CFP.
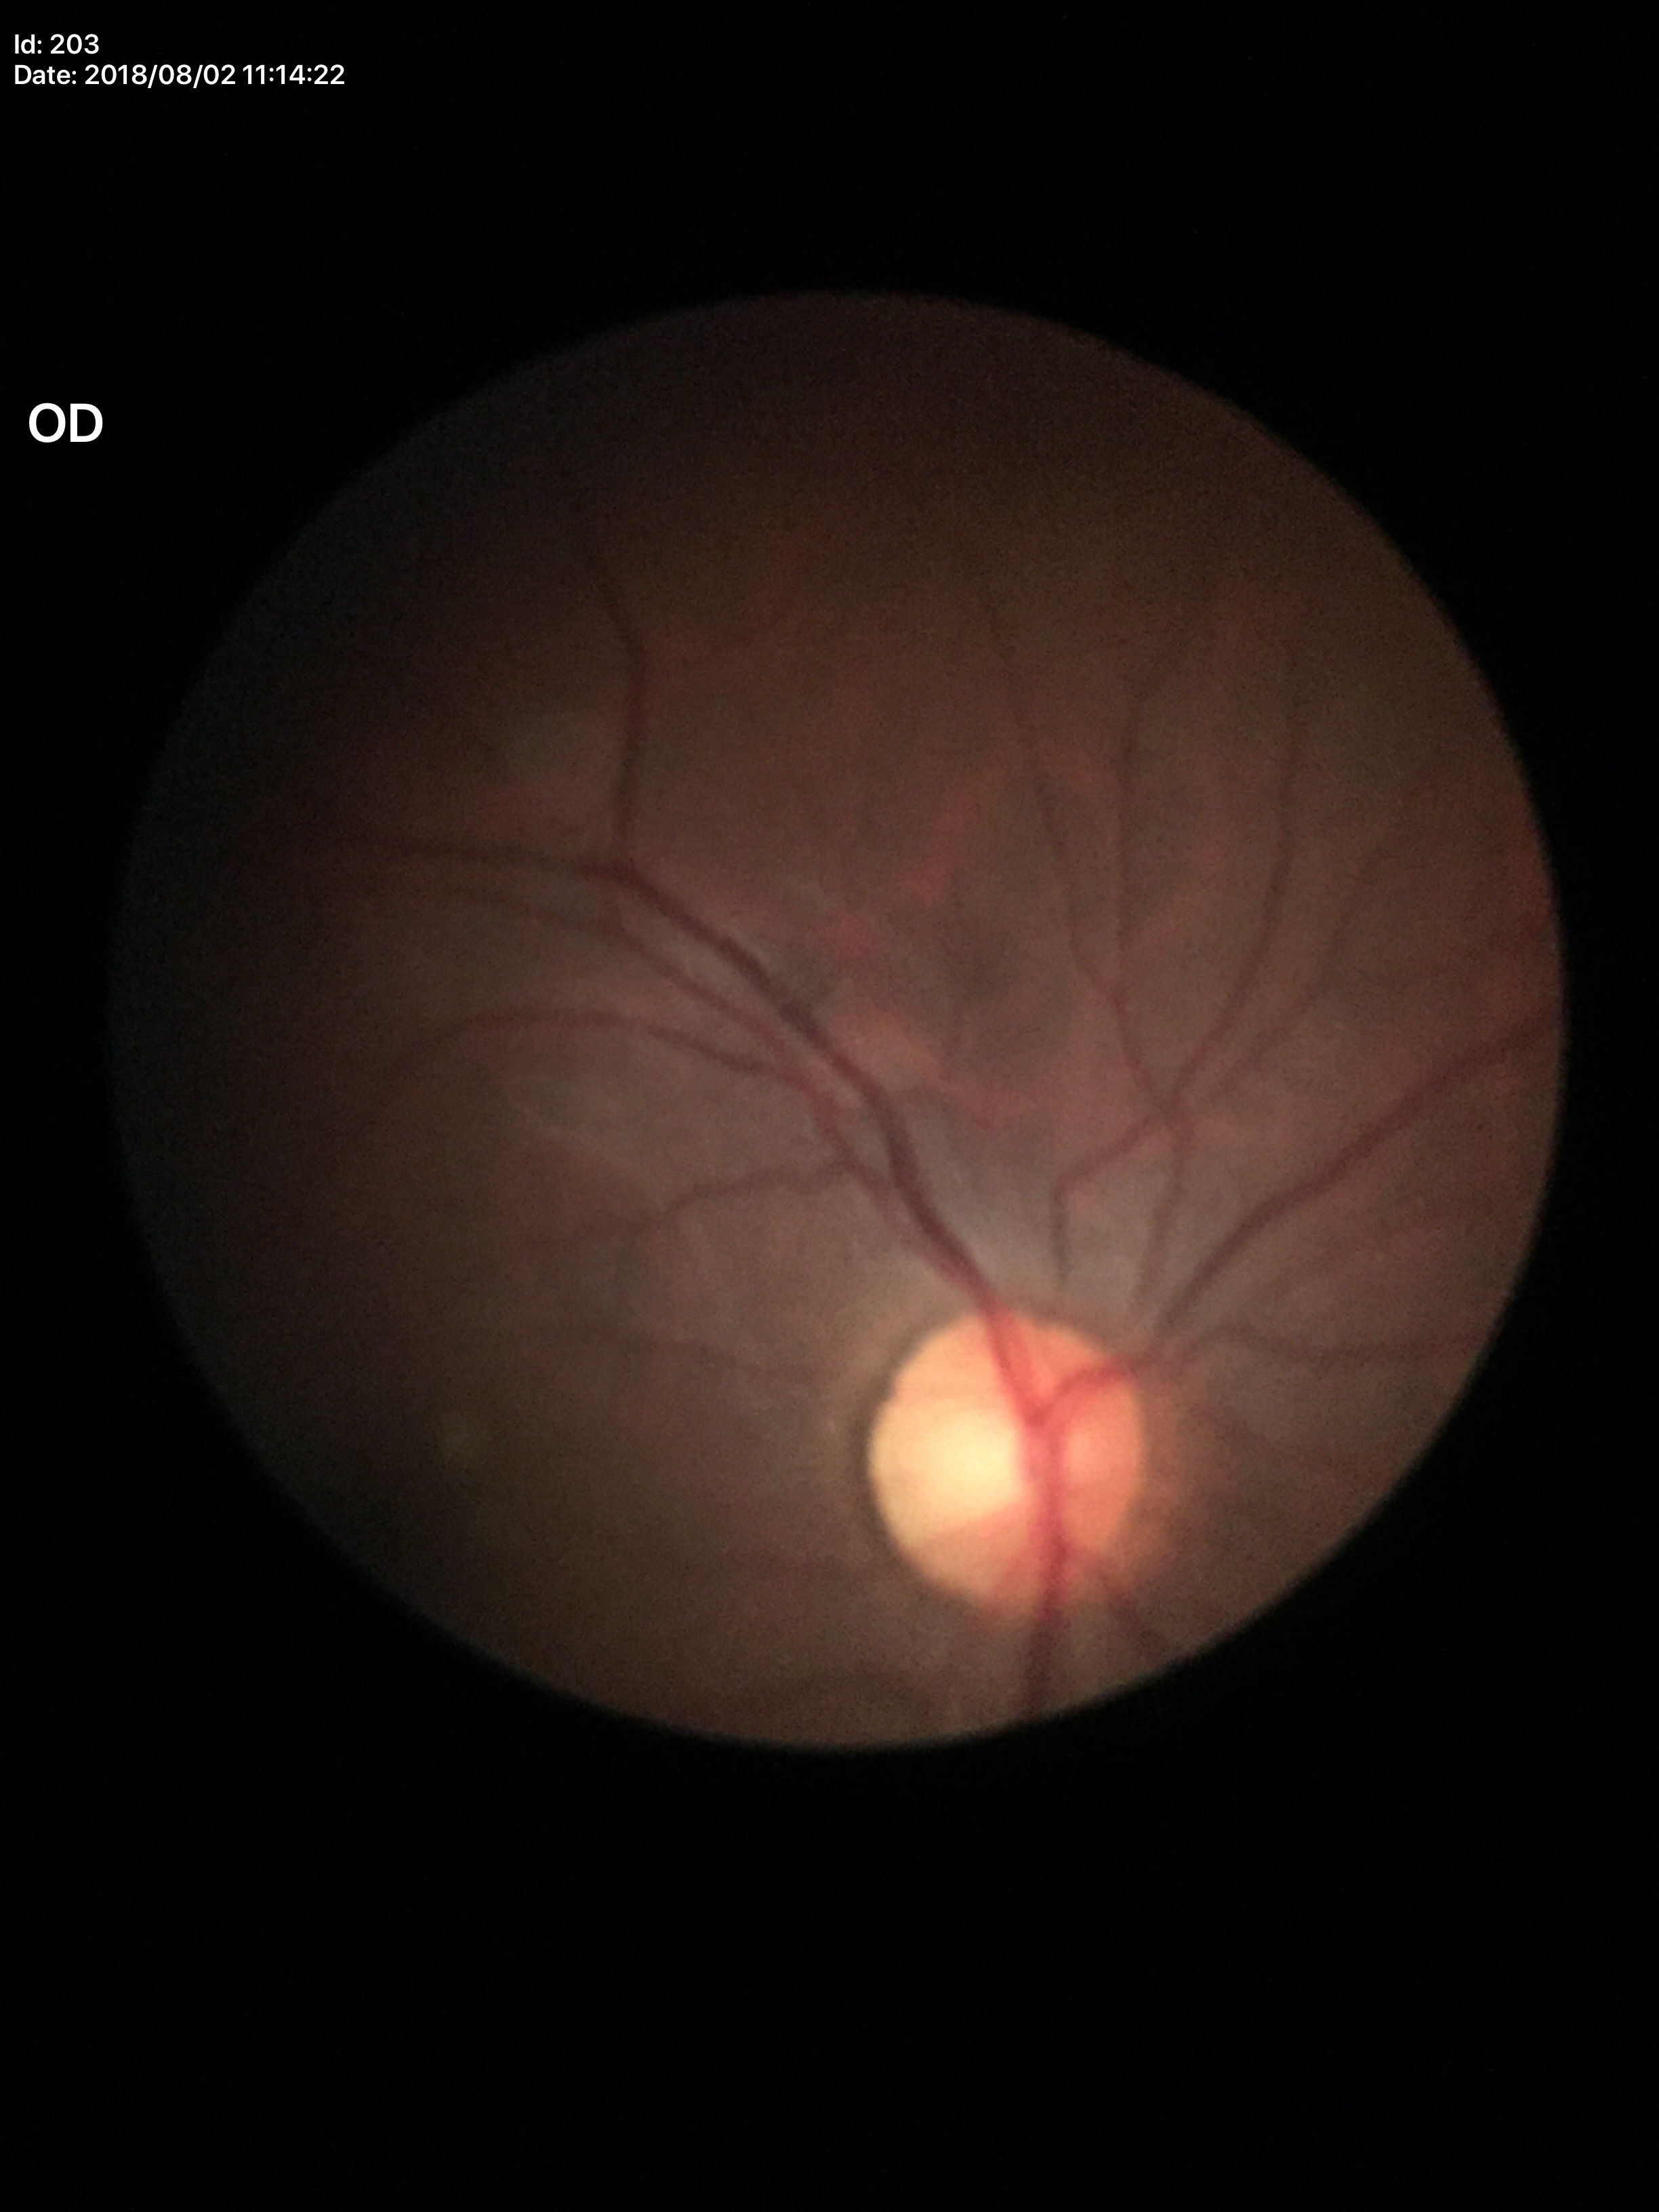
Q: Is there glaucoma suspicion?
A: negative
Q: Vertical CDR?
A: 0.56